Wide-field contact fundus photograph of an infant:
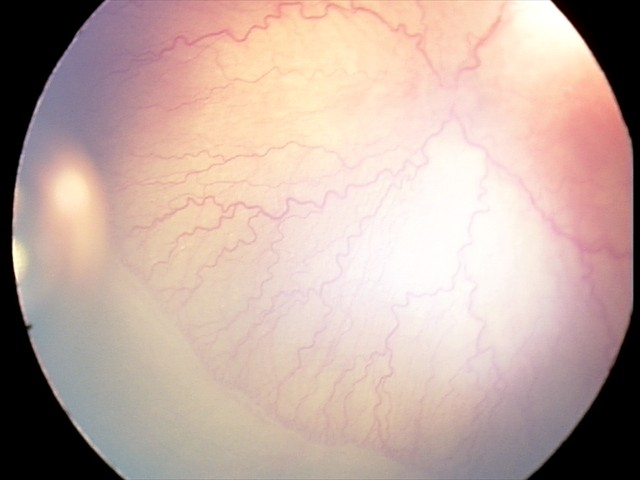

Plus disease was diagnosed. Examination diagnosed as aggressive retinopathy of prematurity (A-ROP).